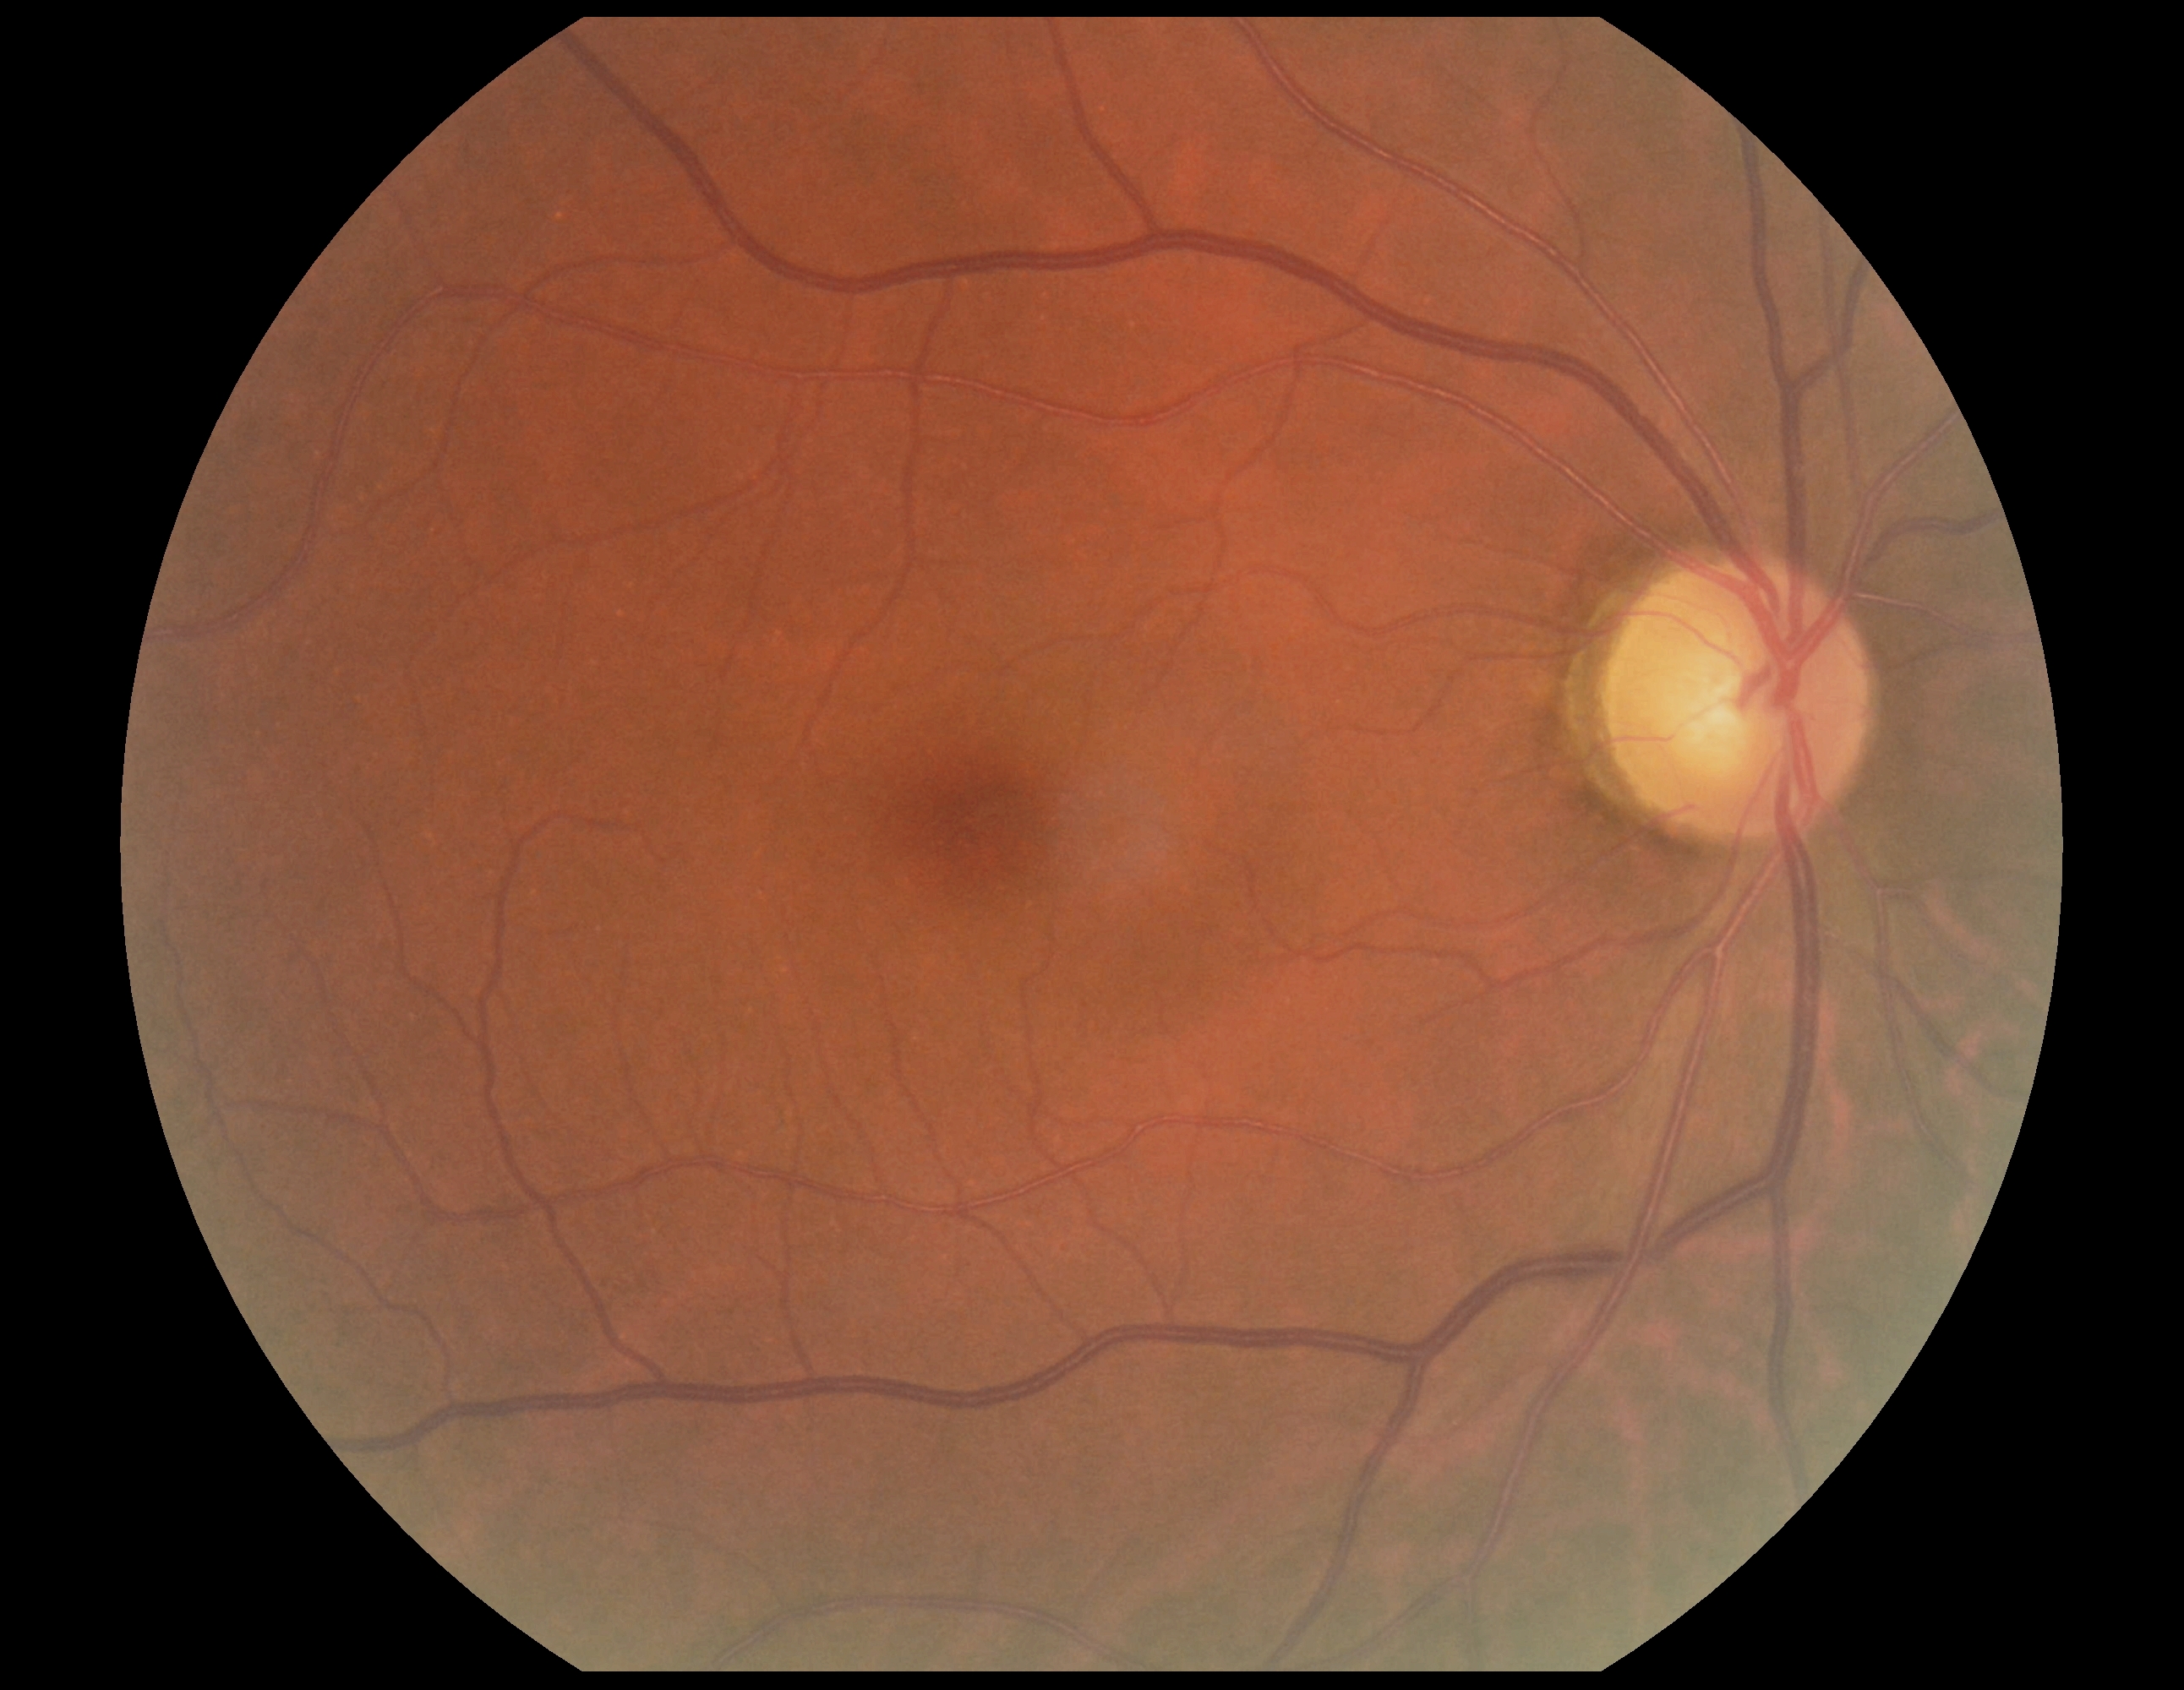

DR severity@grade 0 (no apparent retinopathy), DR impression@negative for DR.